Camera: Nidek AFC-330: 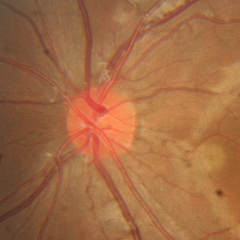
This fundus photograph shows no glaucomatous changes.